Color fundus image, 45-degree field of view: 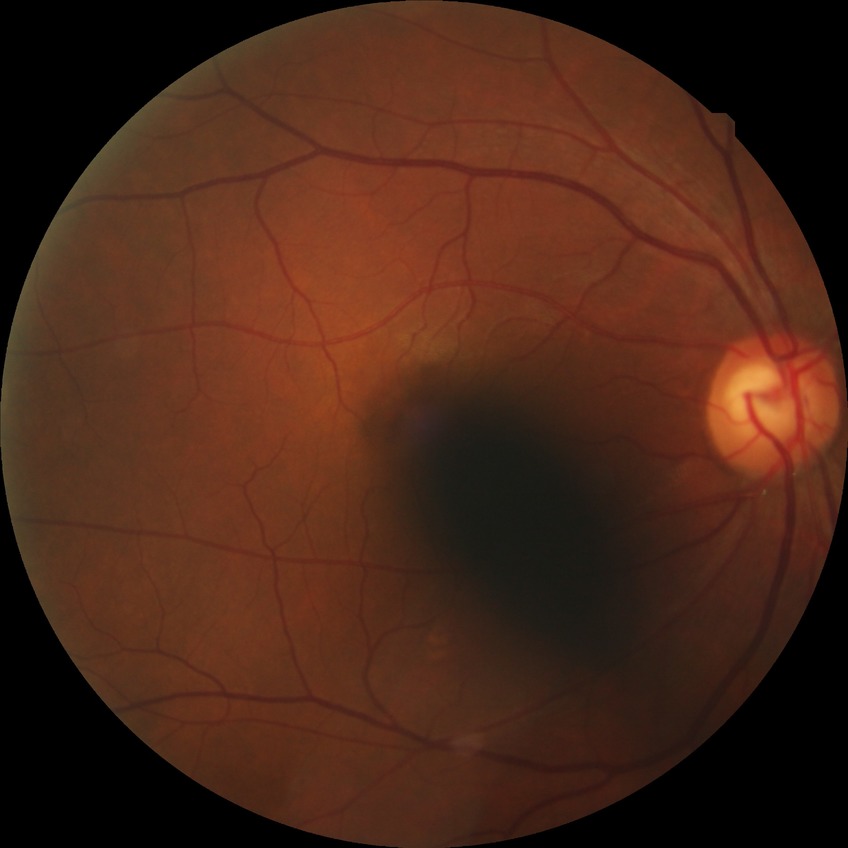
Diabetic retinopathy (DR): NDR (no diabetic retinopathy).